Nonmydriatic · DR severity per modified Davis staging · 45-degree field of view · camera: NIDEK AFC-230.
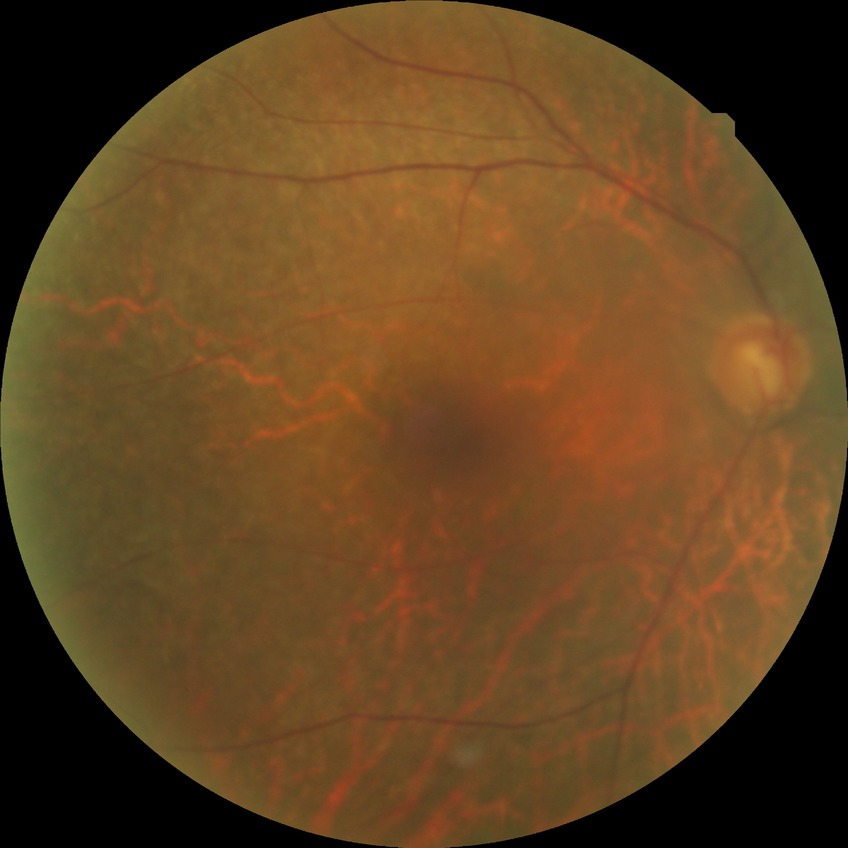
Diabetic retinopathy severity: no diabetic retinopathy.